848 by 848 pixels · retinal fundus photograph · nonmydriatic fundus photograph · camera: NIDEK AFC-230
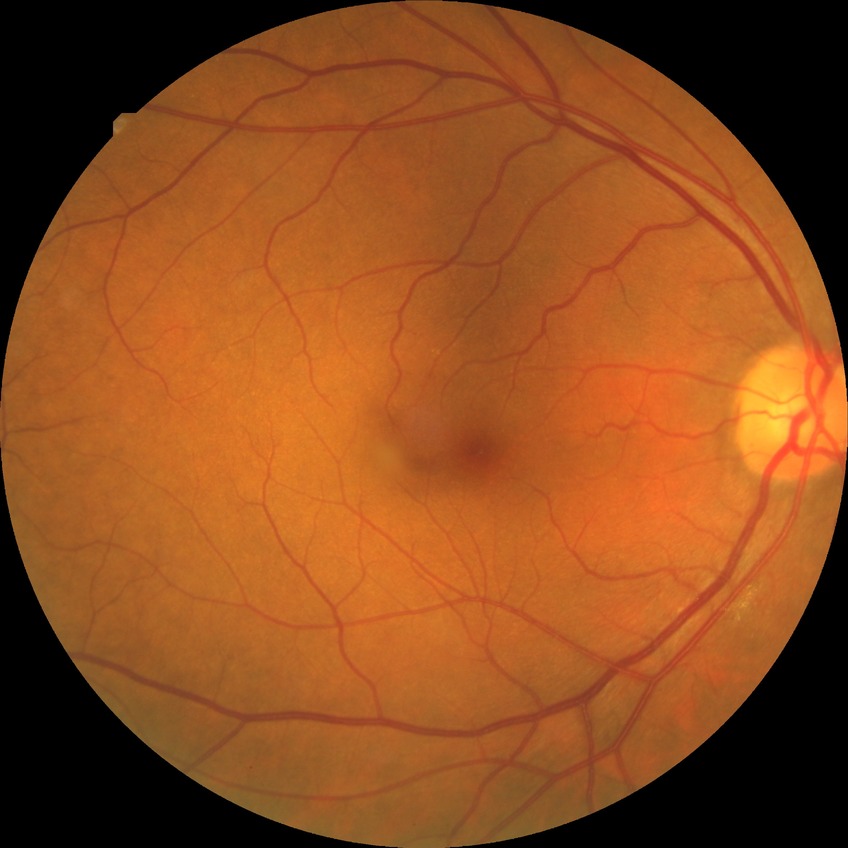
Diabetic retinopathy (DR) is NDR (no diabetic retinopathy).